Color fundus image, 2184 by 1690 pixels: 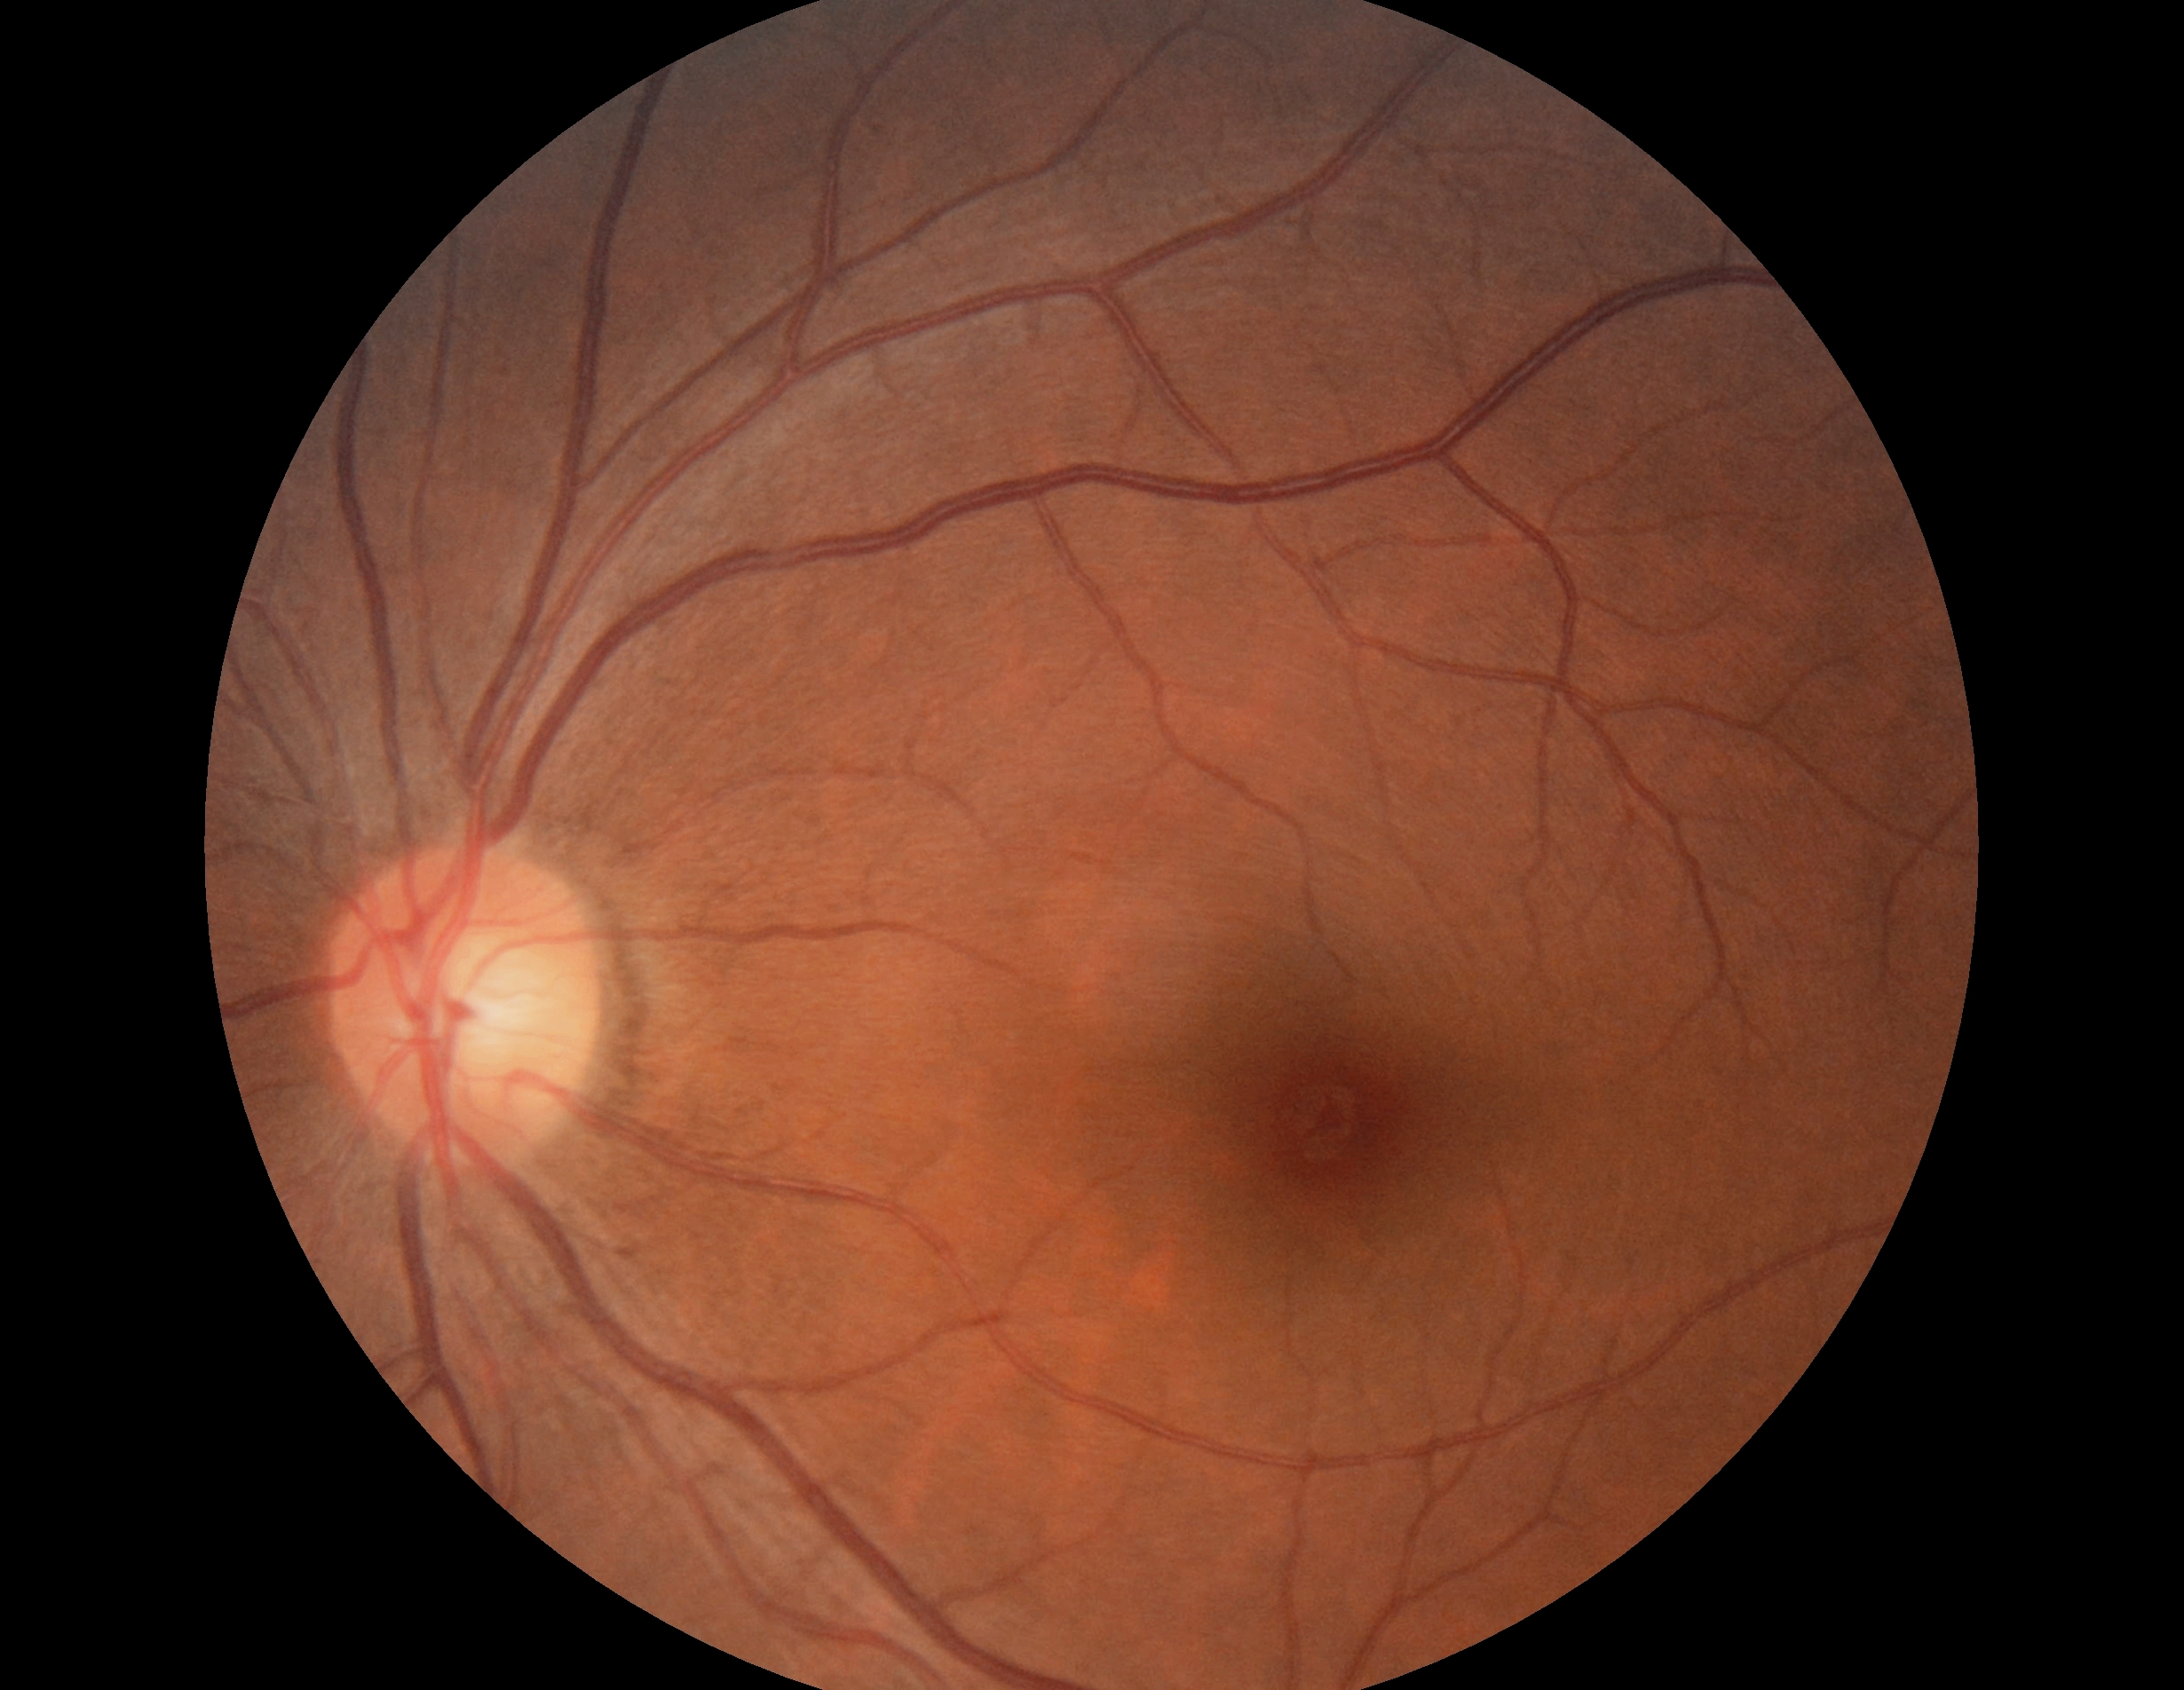

Findings:
- DR stage: grade 0 — no visible signs of diabetic retinopathy